640 x 480 pixels. Infant wide-field retinal image
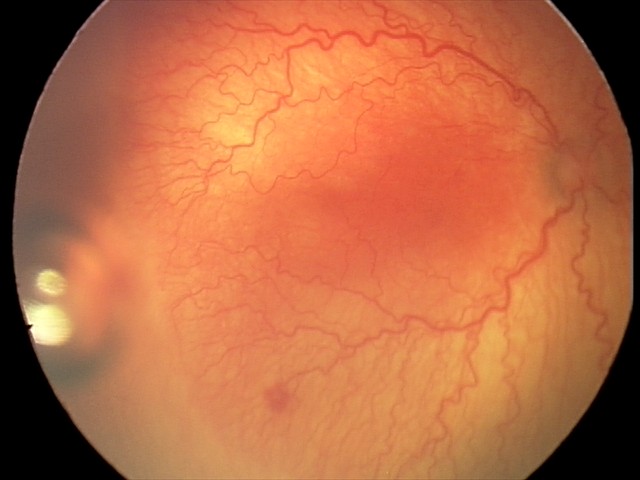

Series diagnosed as aggressive retinopathy of prematurity — rapidly progressive severe ROP with prominent plus disease, often without classic stage progression.